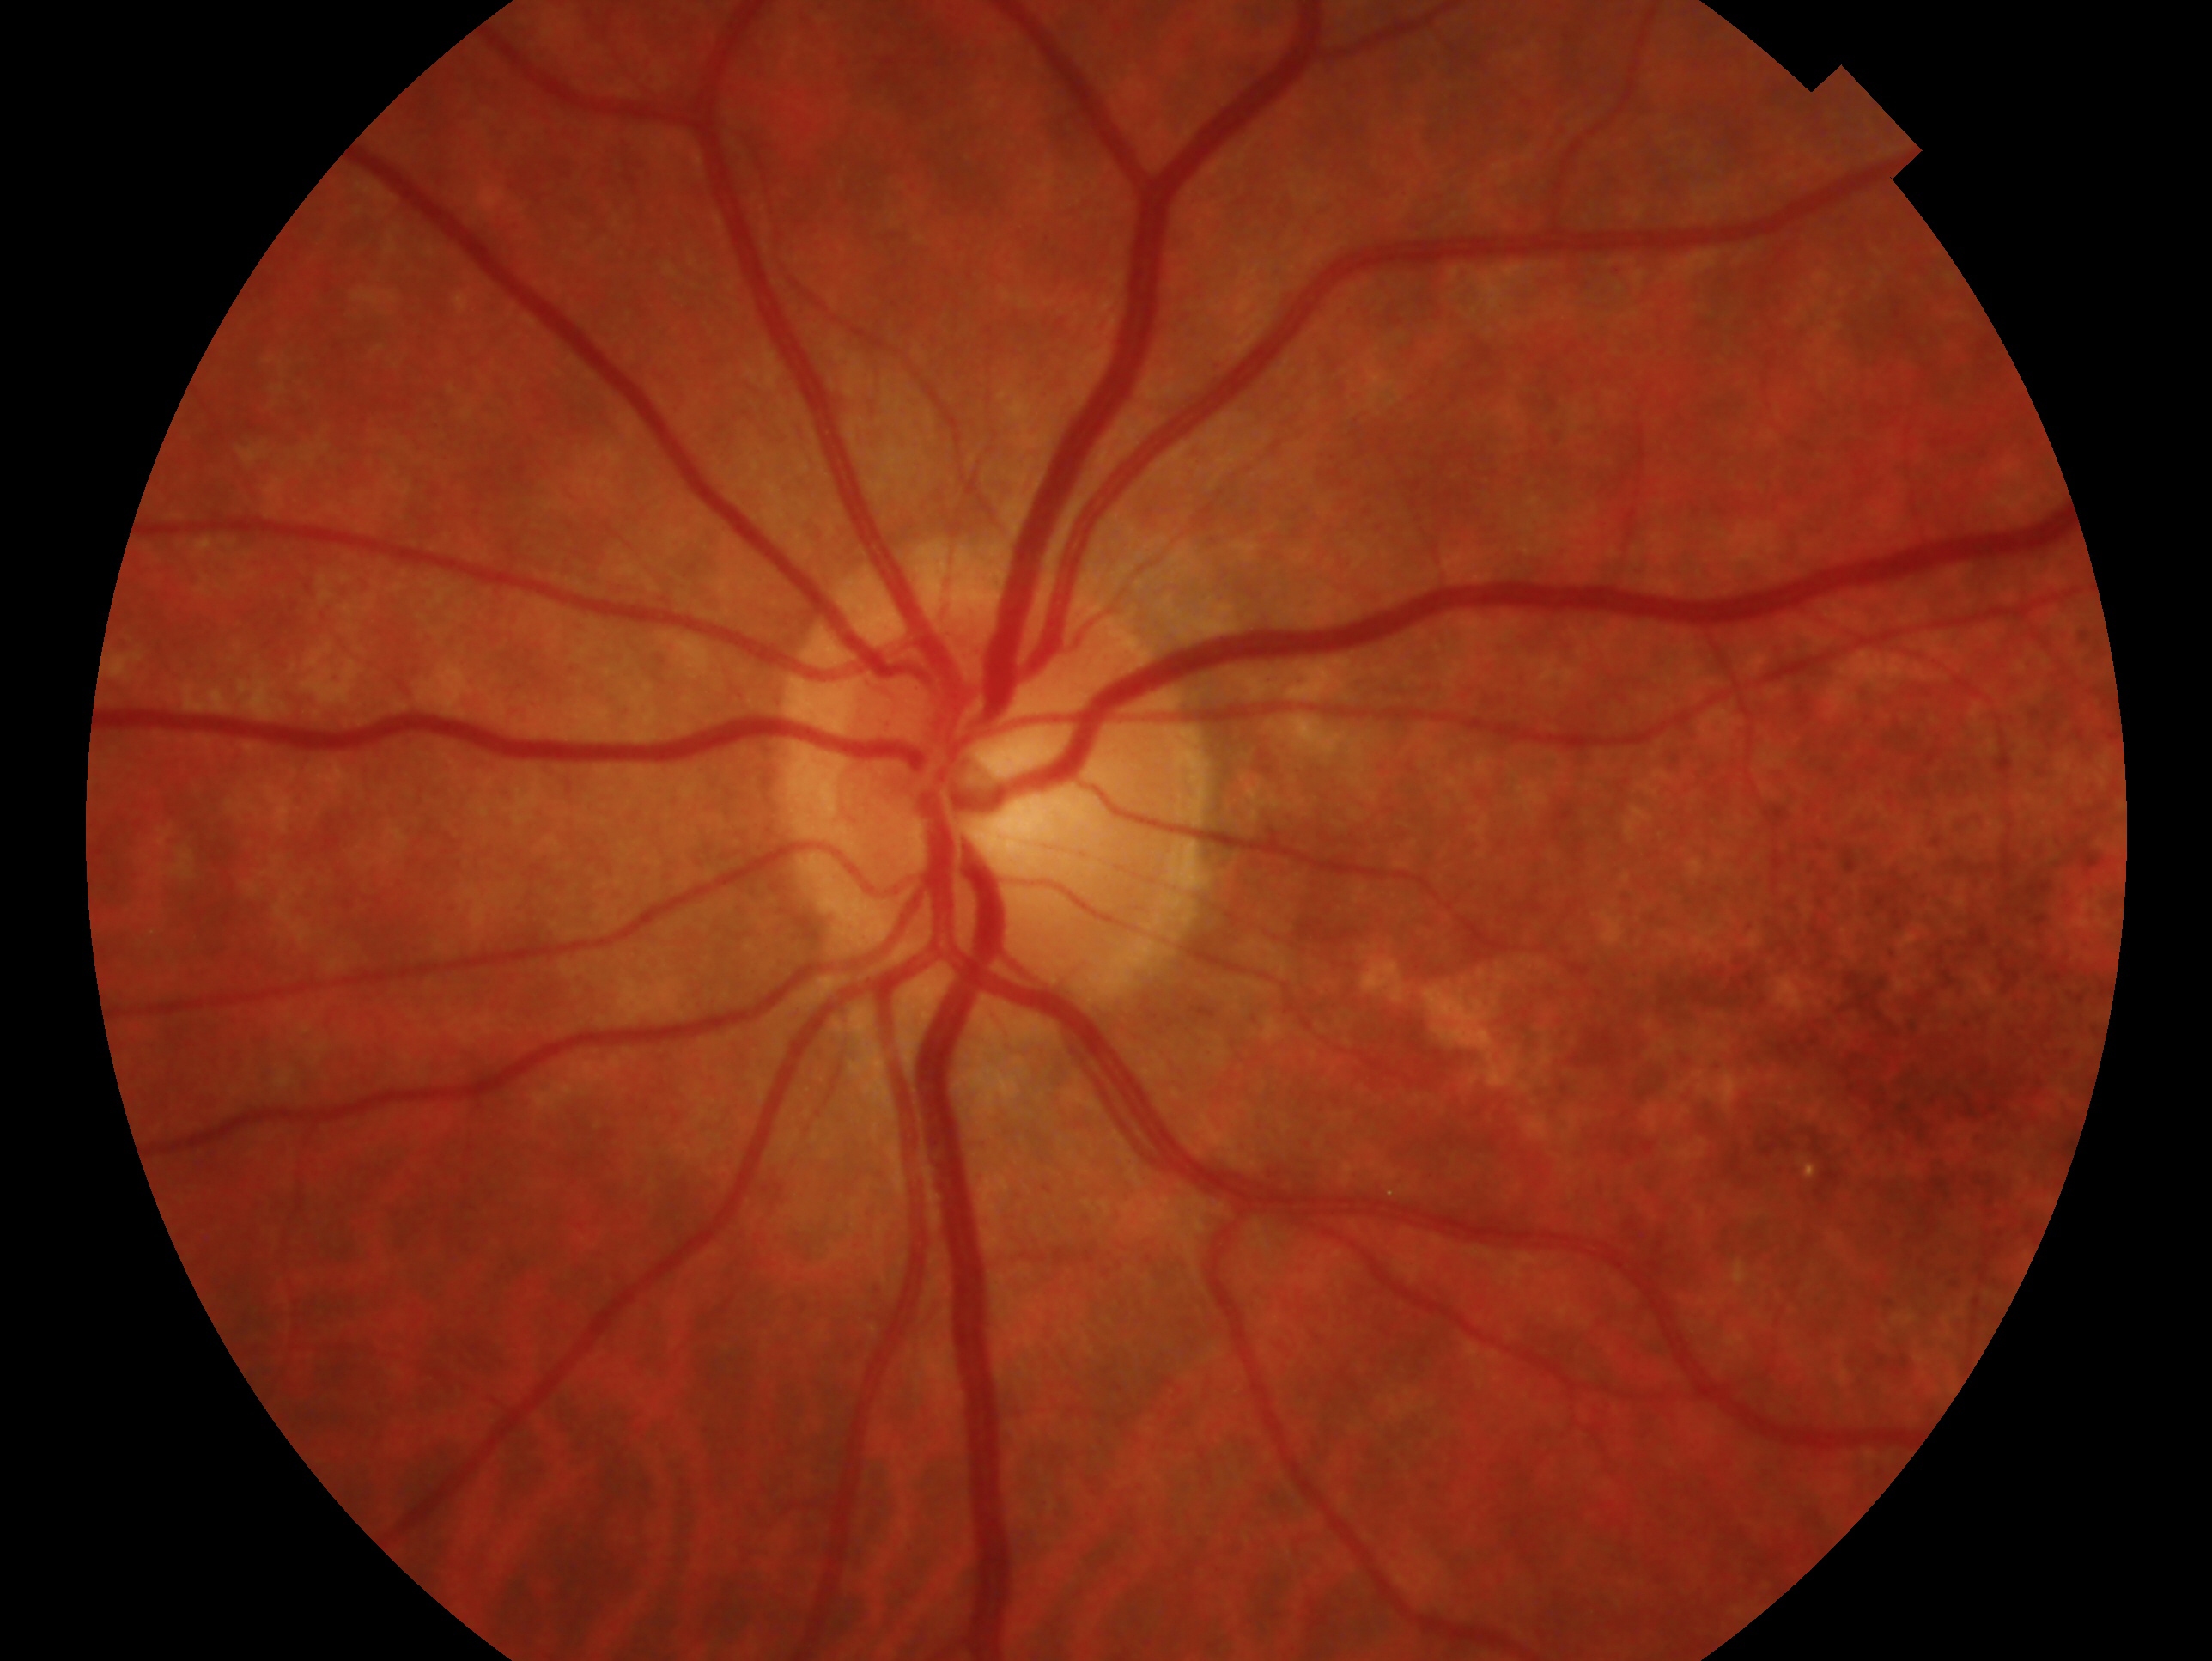

Glaucoma assessment — no glaucoma.
Imaged eye: left eye.